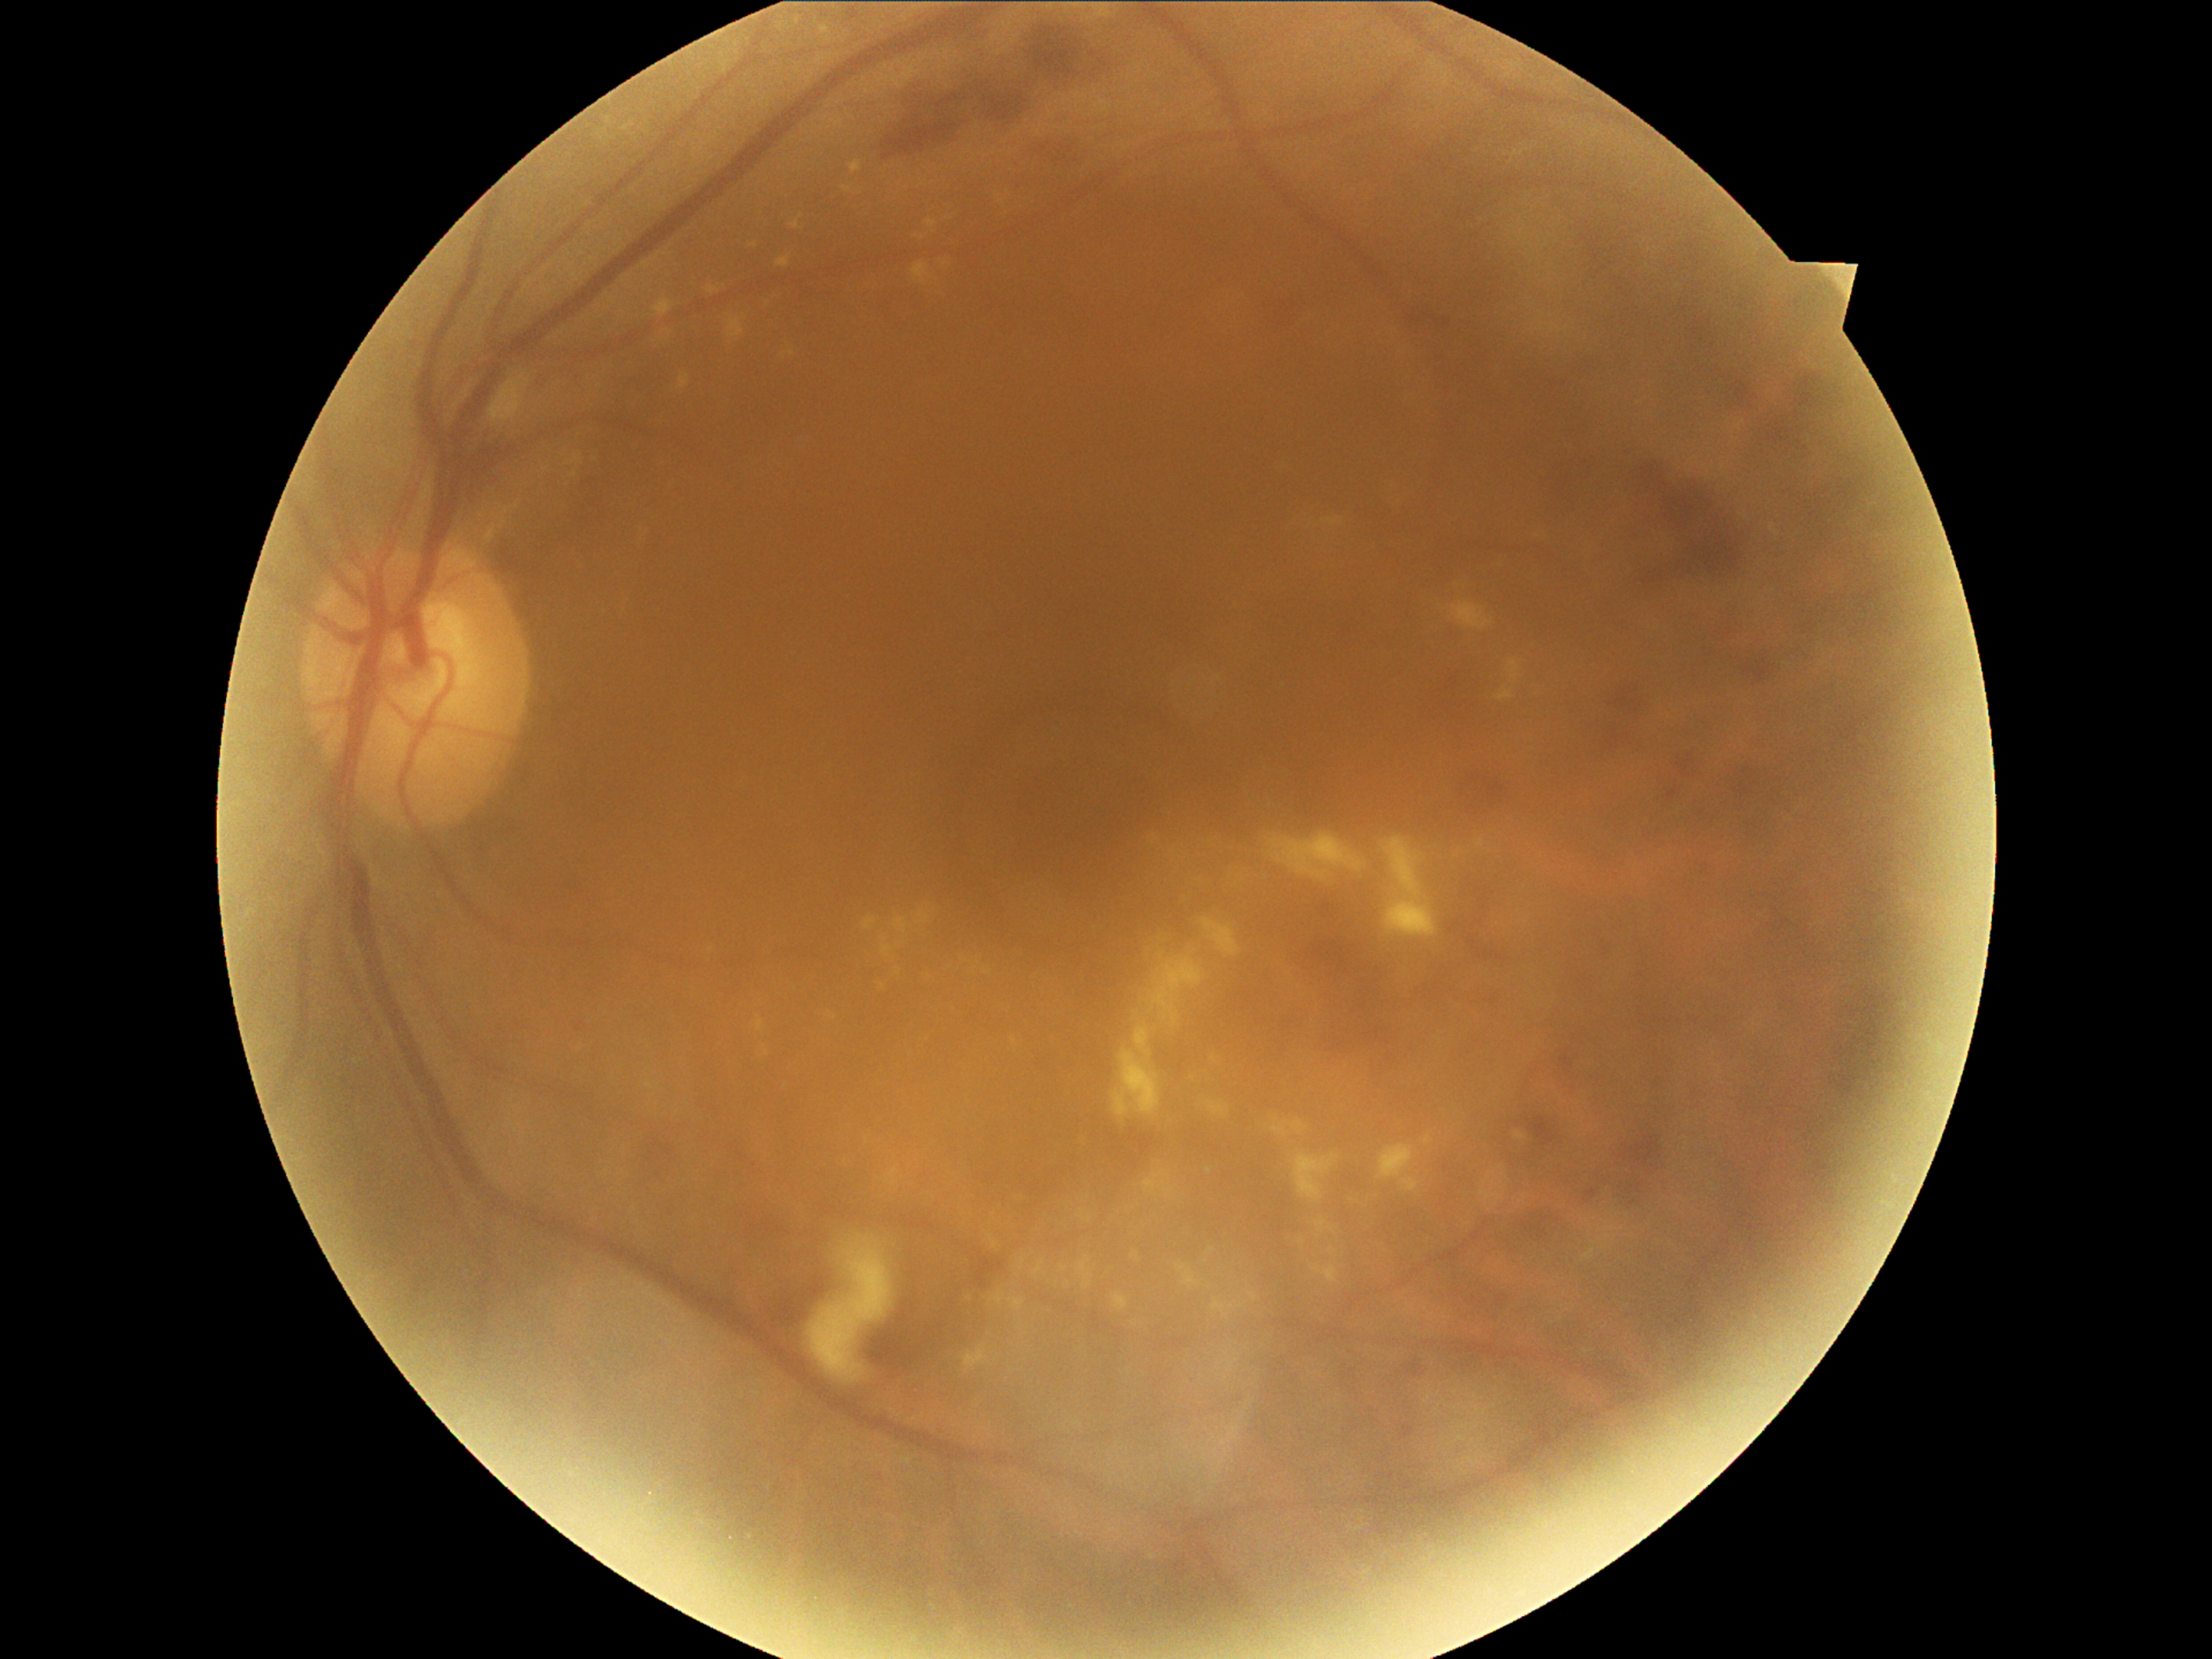

retinopathy=2.